Captured after pupil dilation; FOV: 50 degrees.
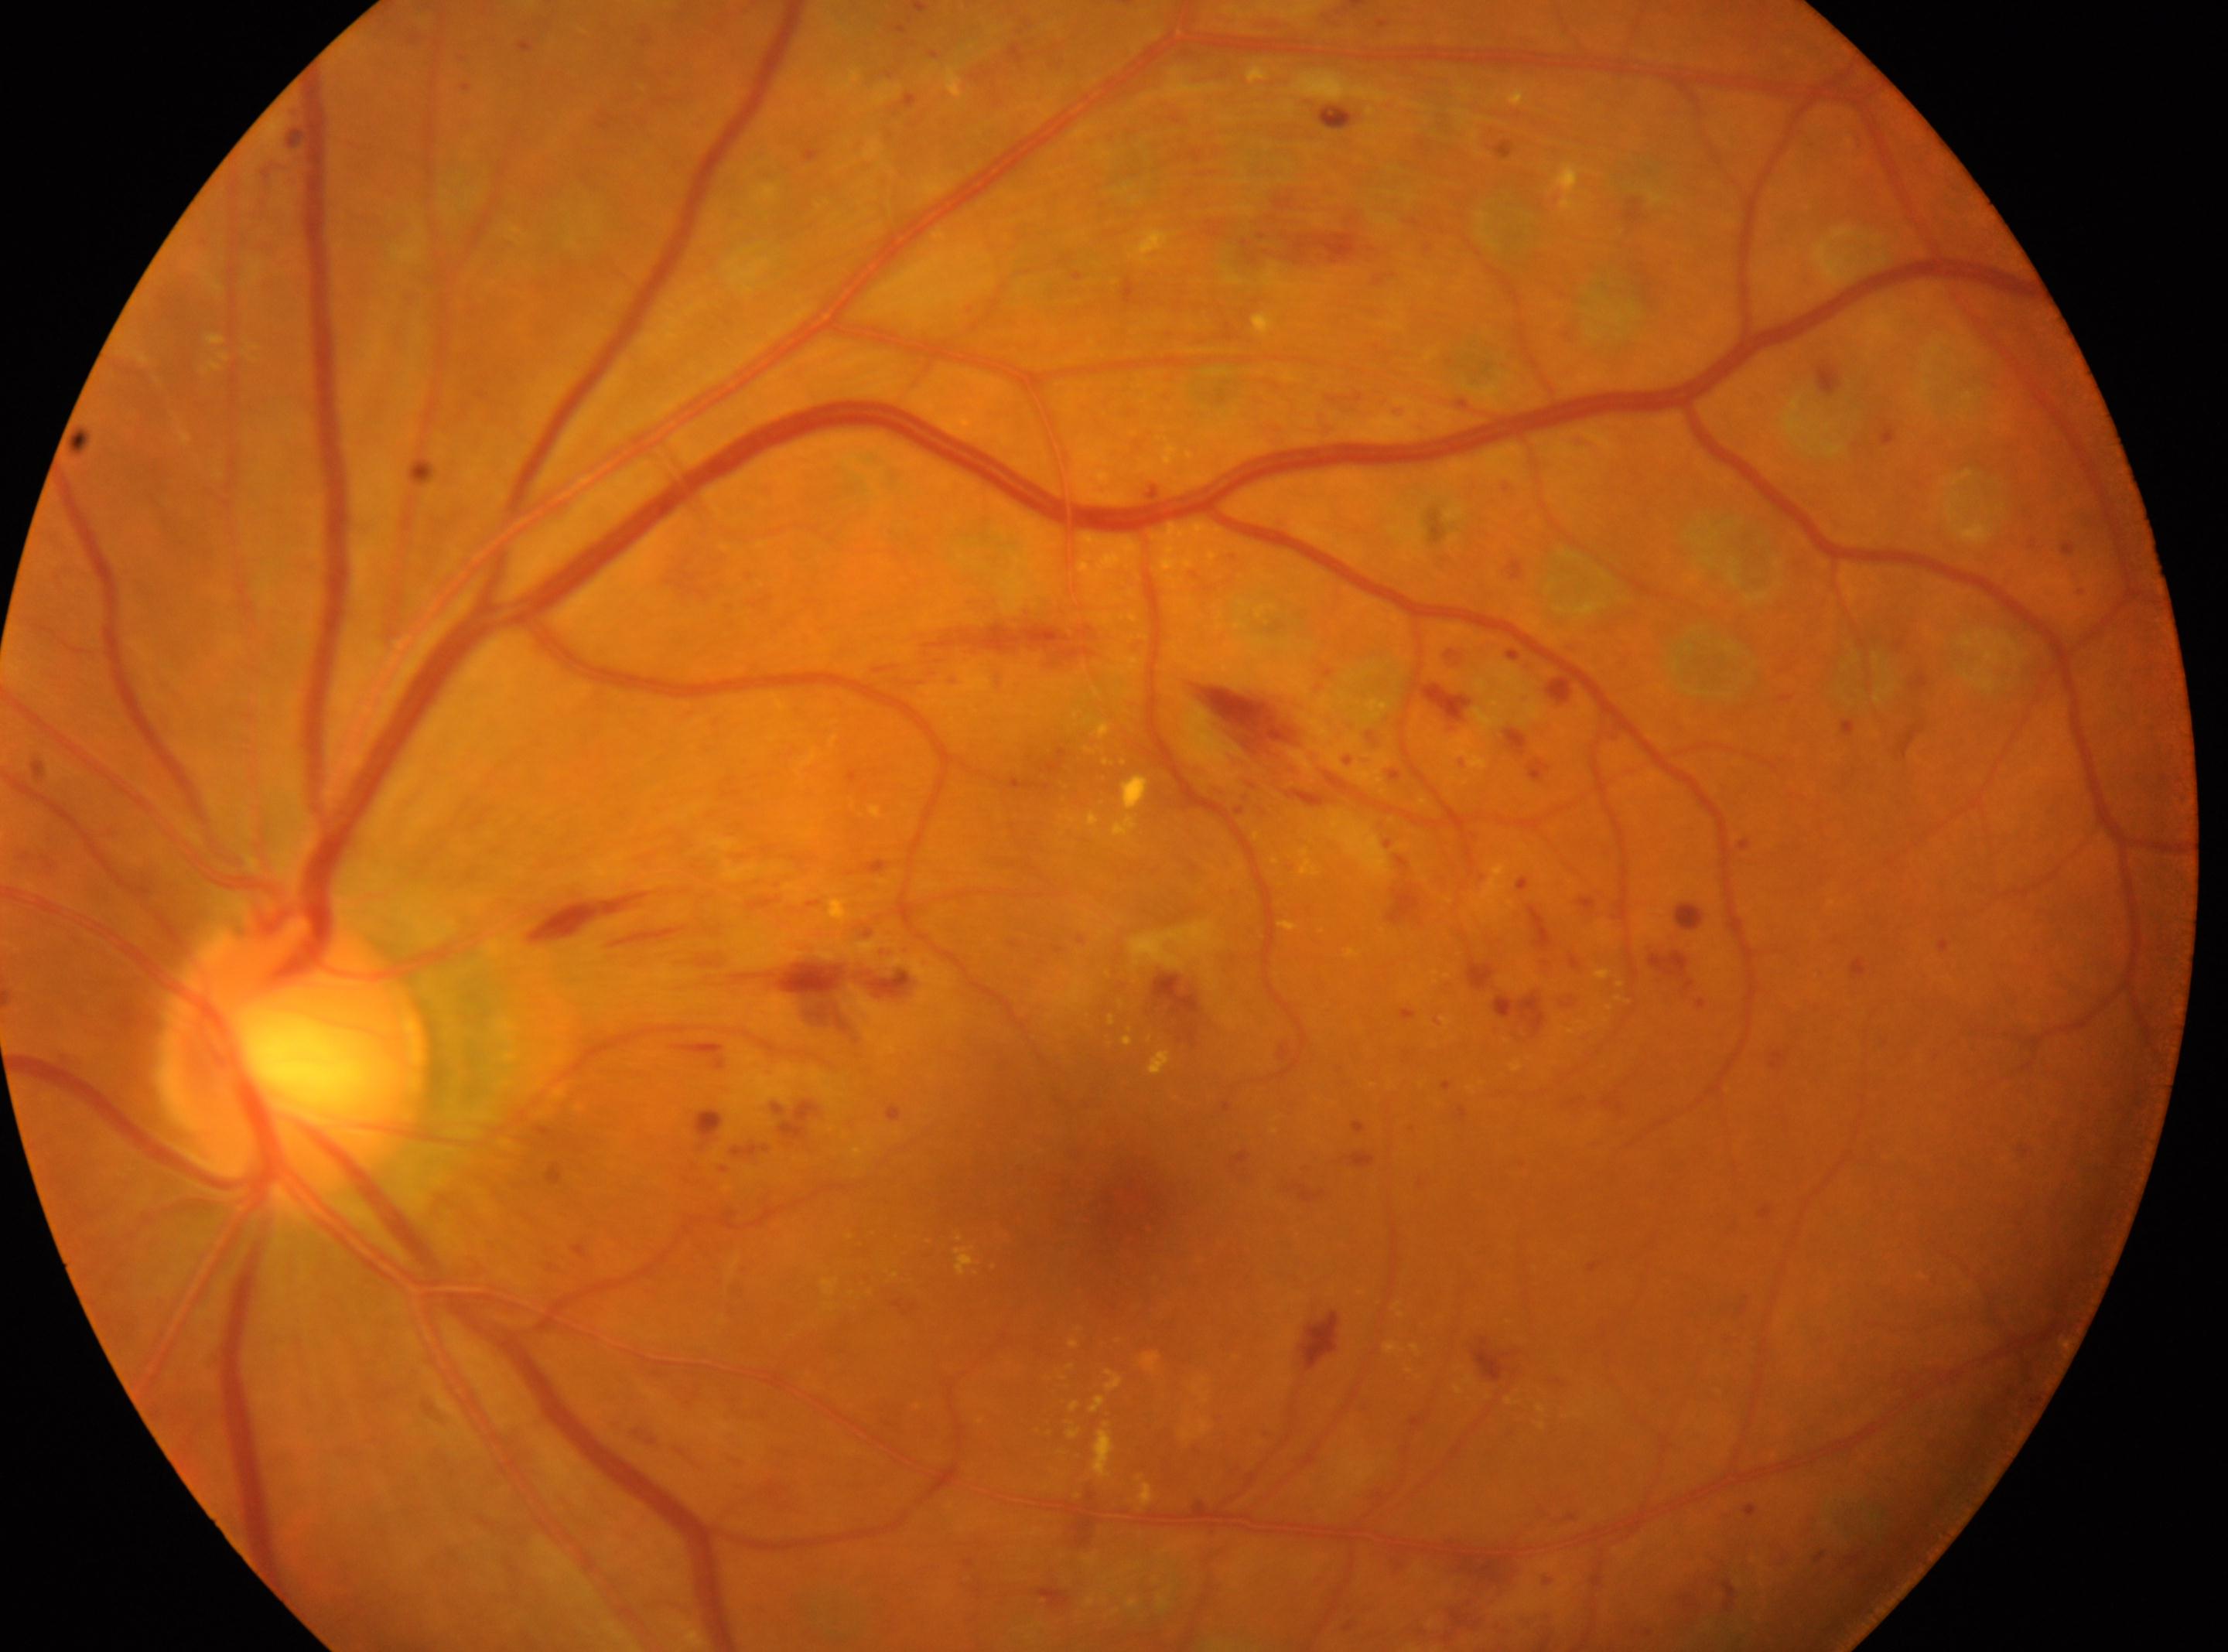
DR severity: DR with laser spots or scars, underlying severity severe non-proliferative diabetic retinopathy (grade 3) | foveal center: (1126, 1199) | left eye | optic disc center: (291, 1056).